Non-mydriatic acquisition:
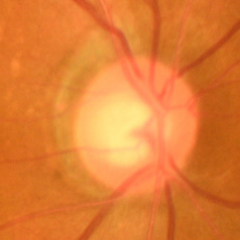 Diagnosis = early glaucomatous changes.